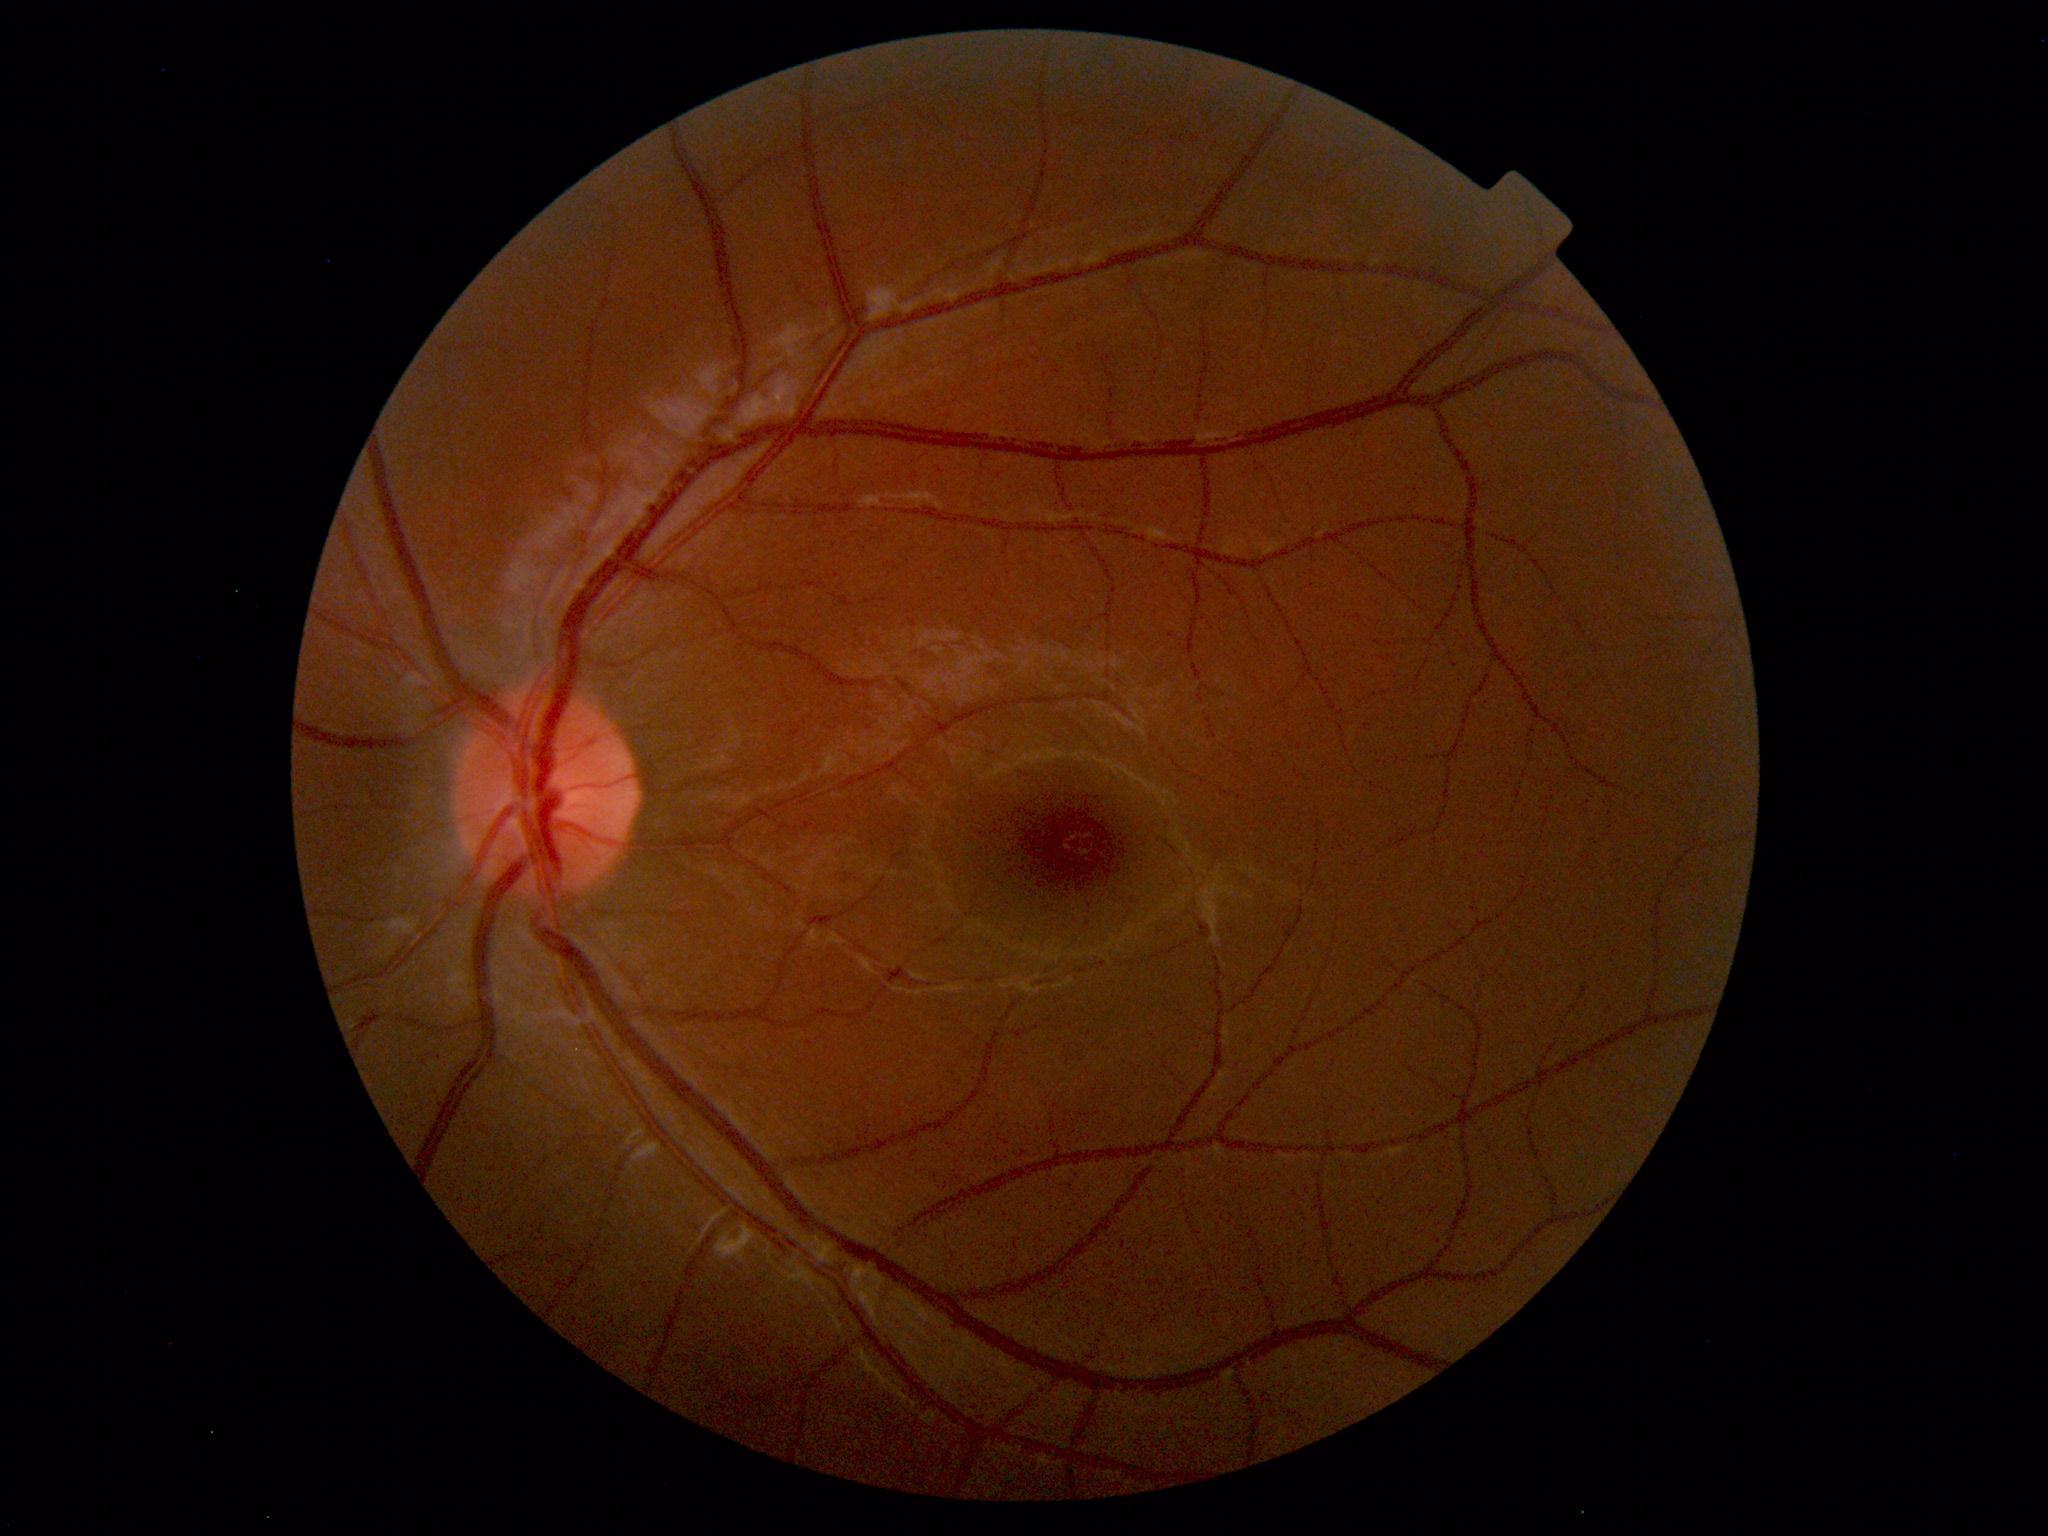 Normal fundus appearance.